45° field of view; 848 x 848 pixels
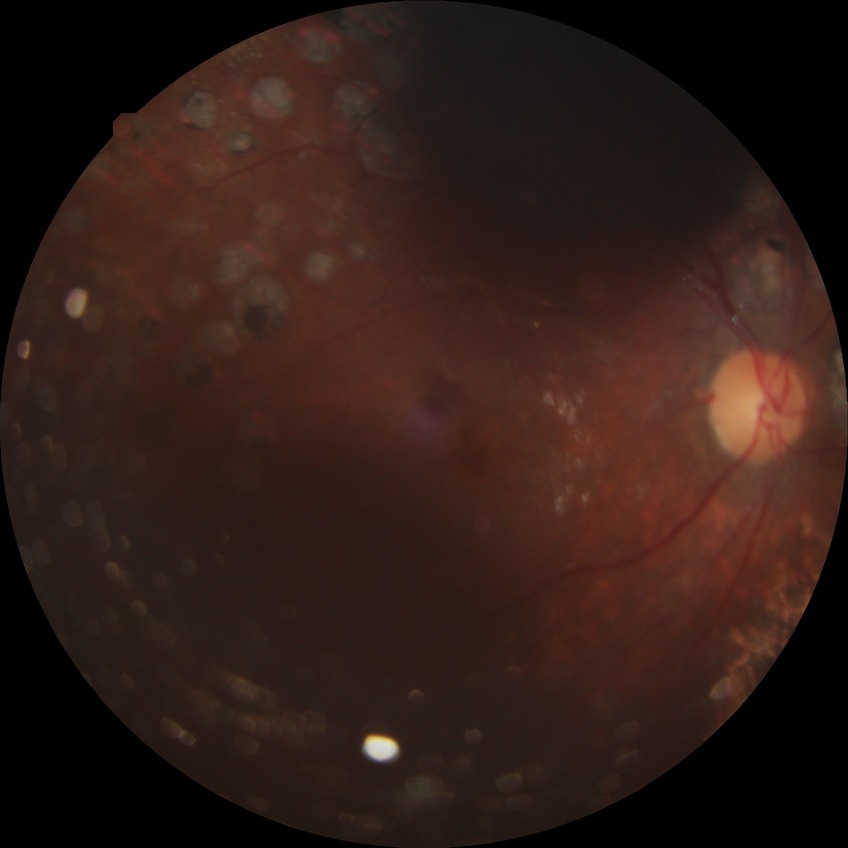 Modified Davis classification: proliferative diabetic retinopathy.